Topcon TRC-50DX: 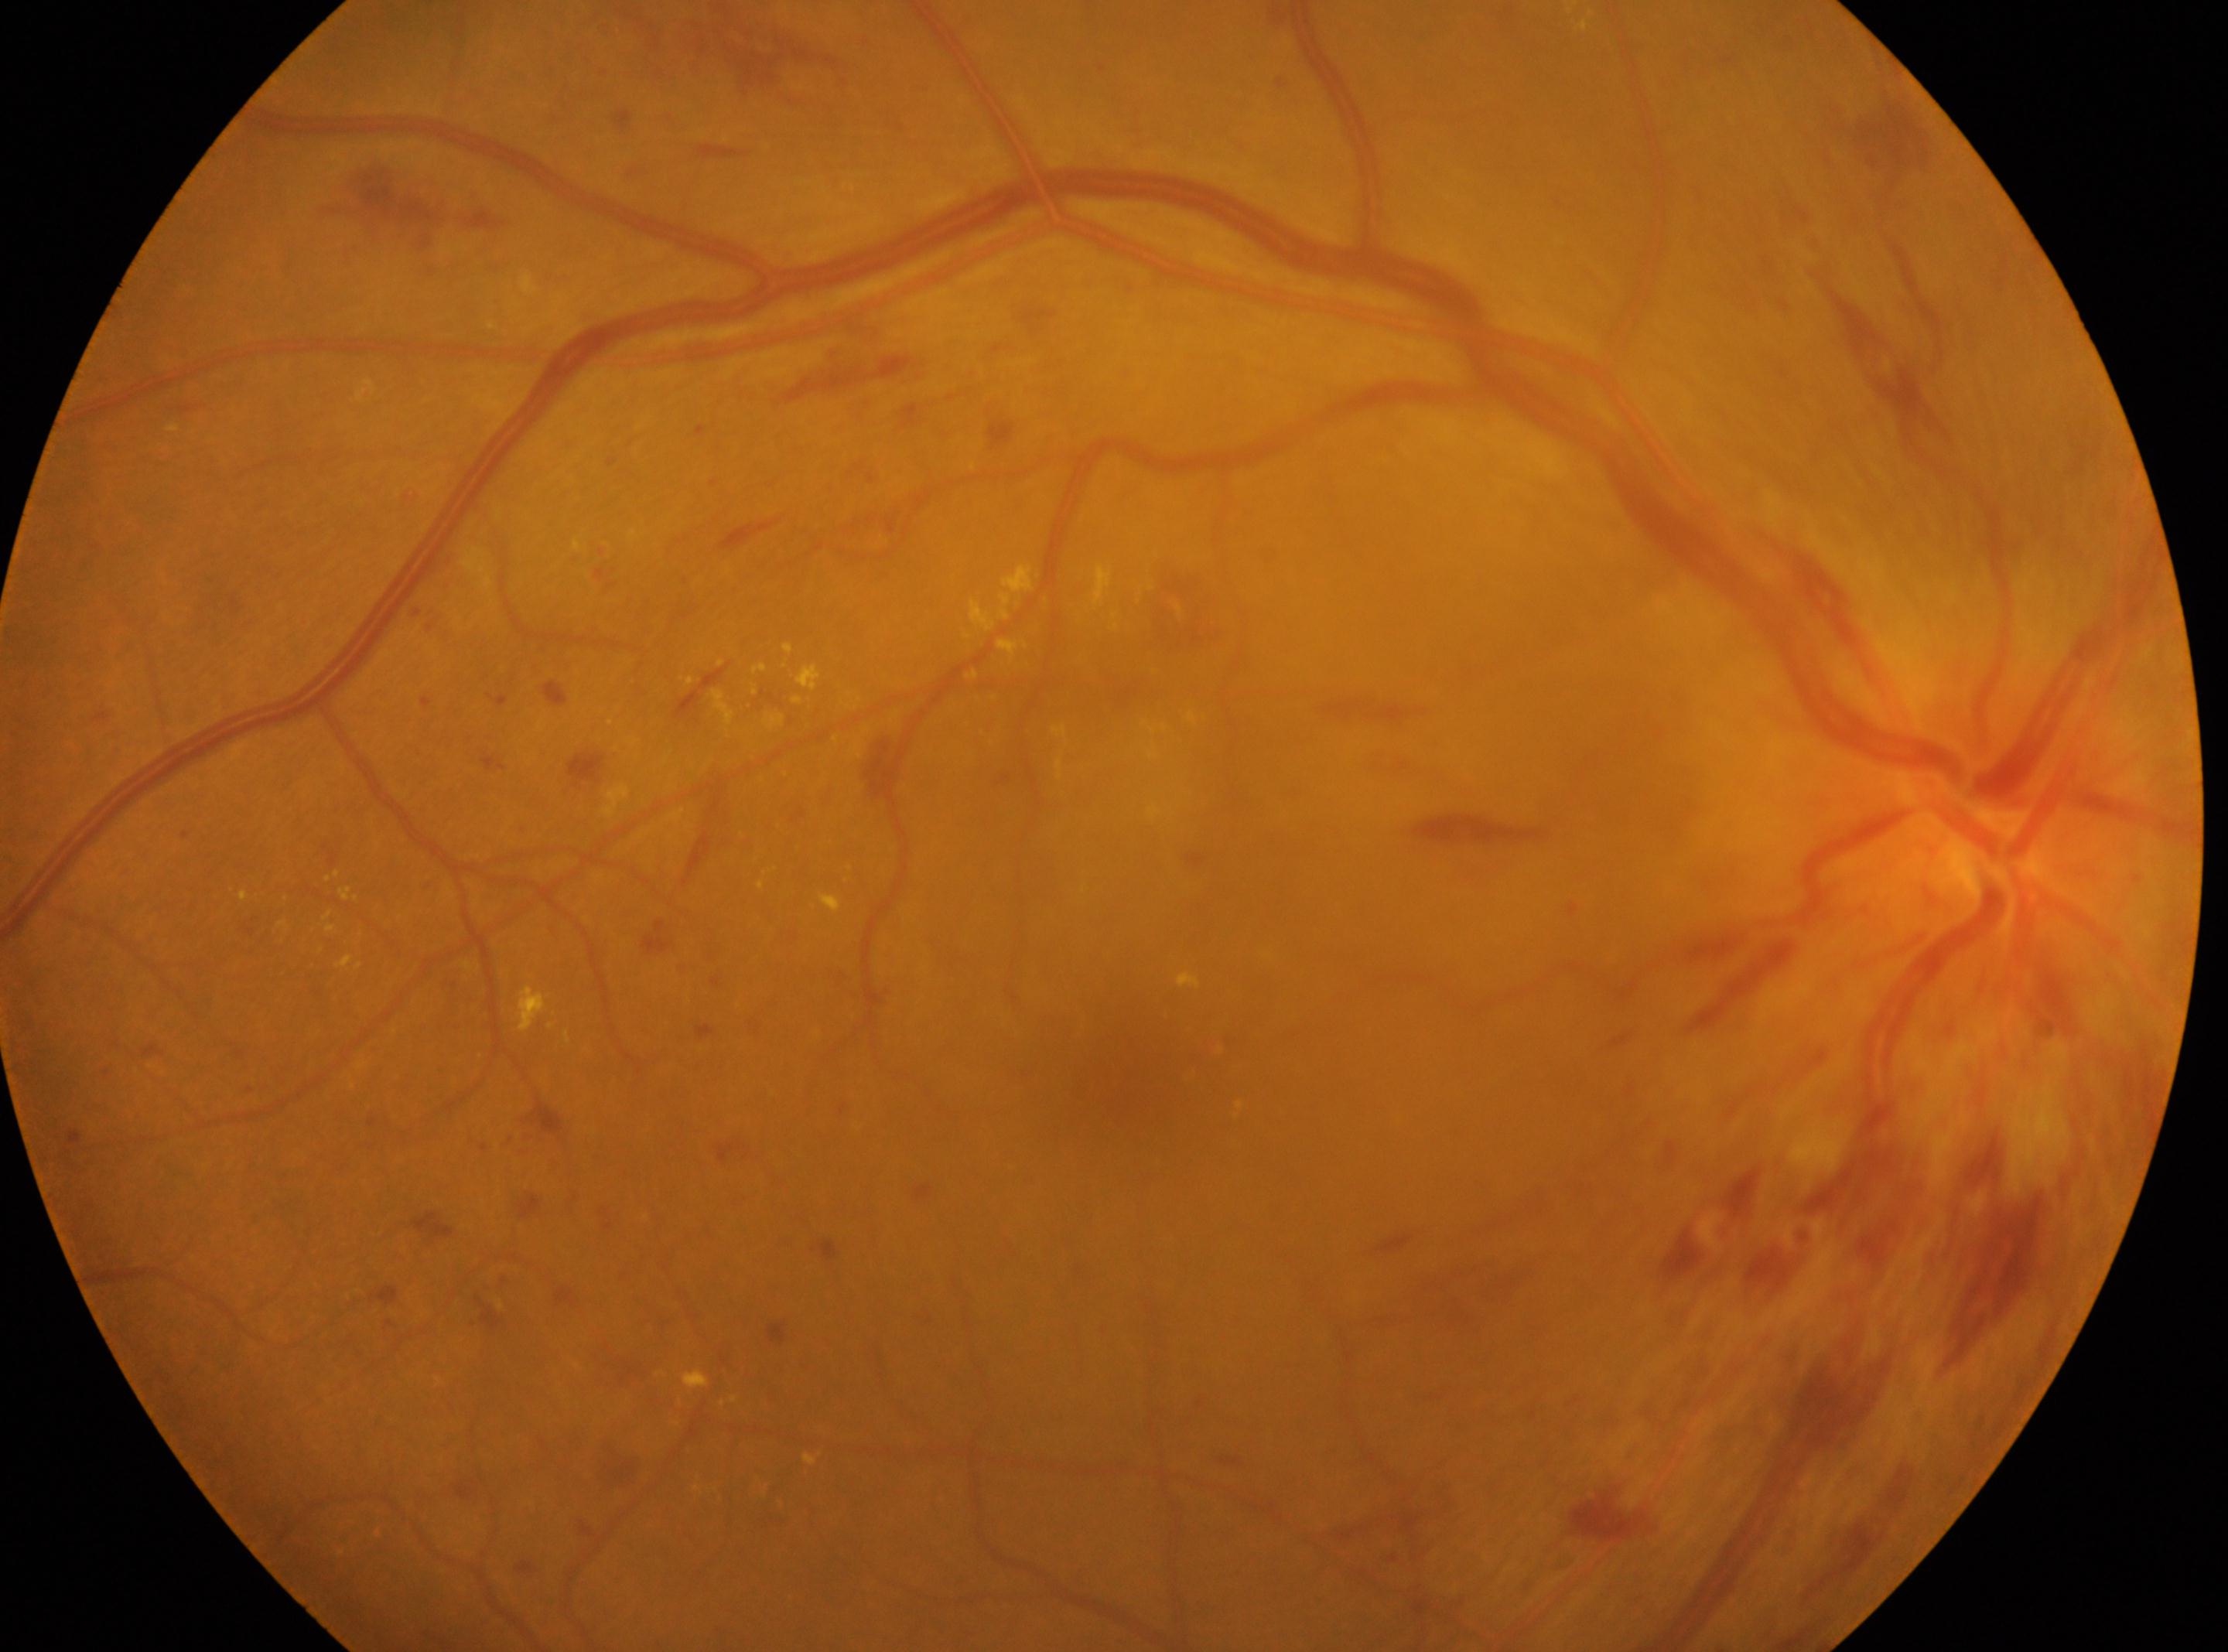
Fovea located at (1134, 1081).
This is the right eye.
DR severity is grade 3.
Optic disc: (1982, 840).